2048x1536px.
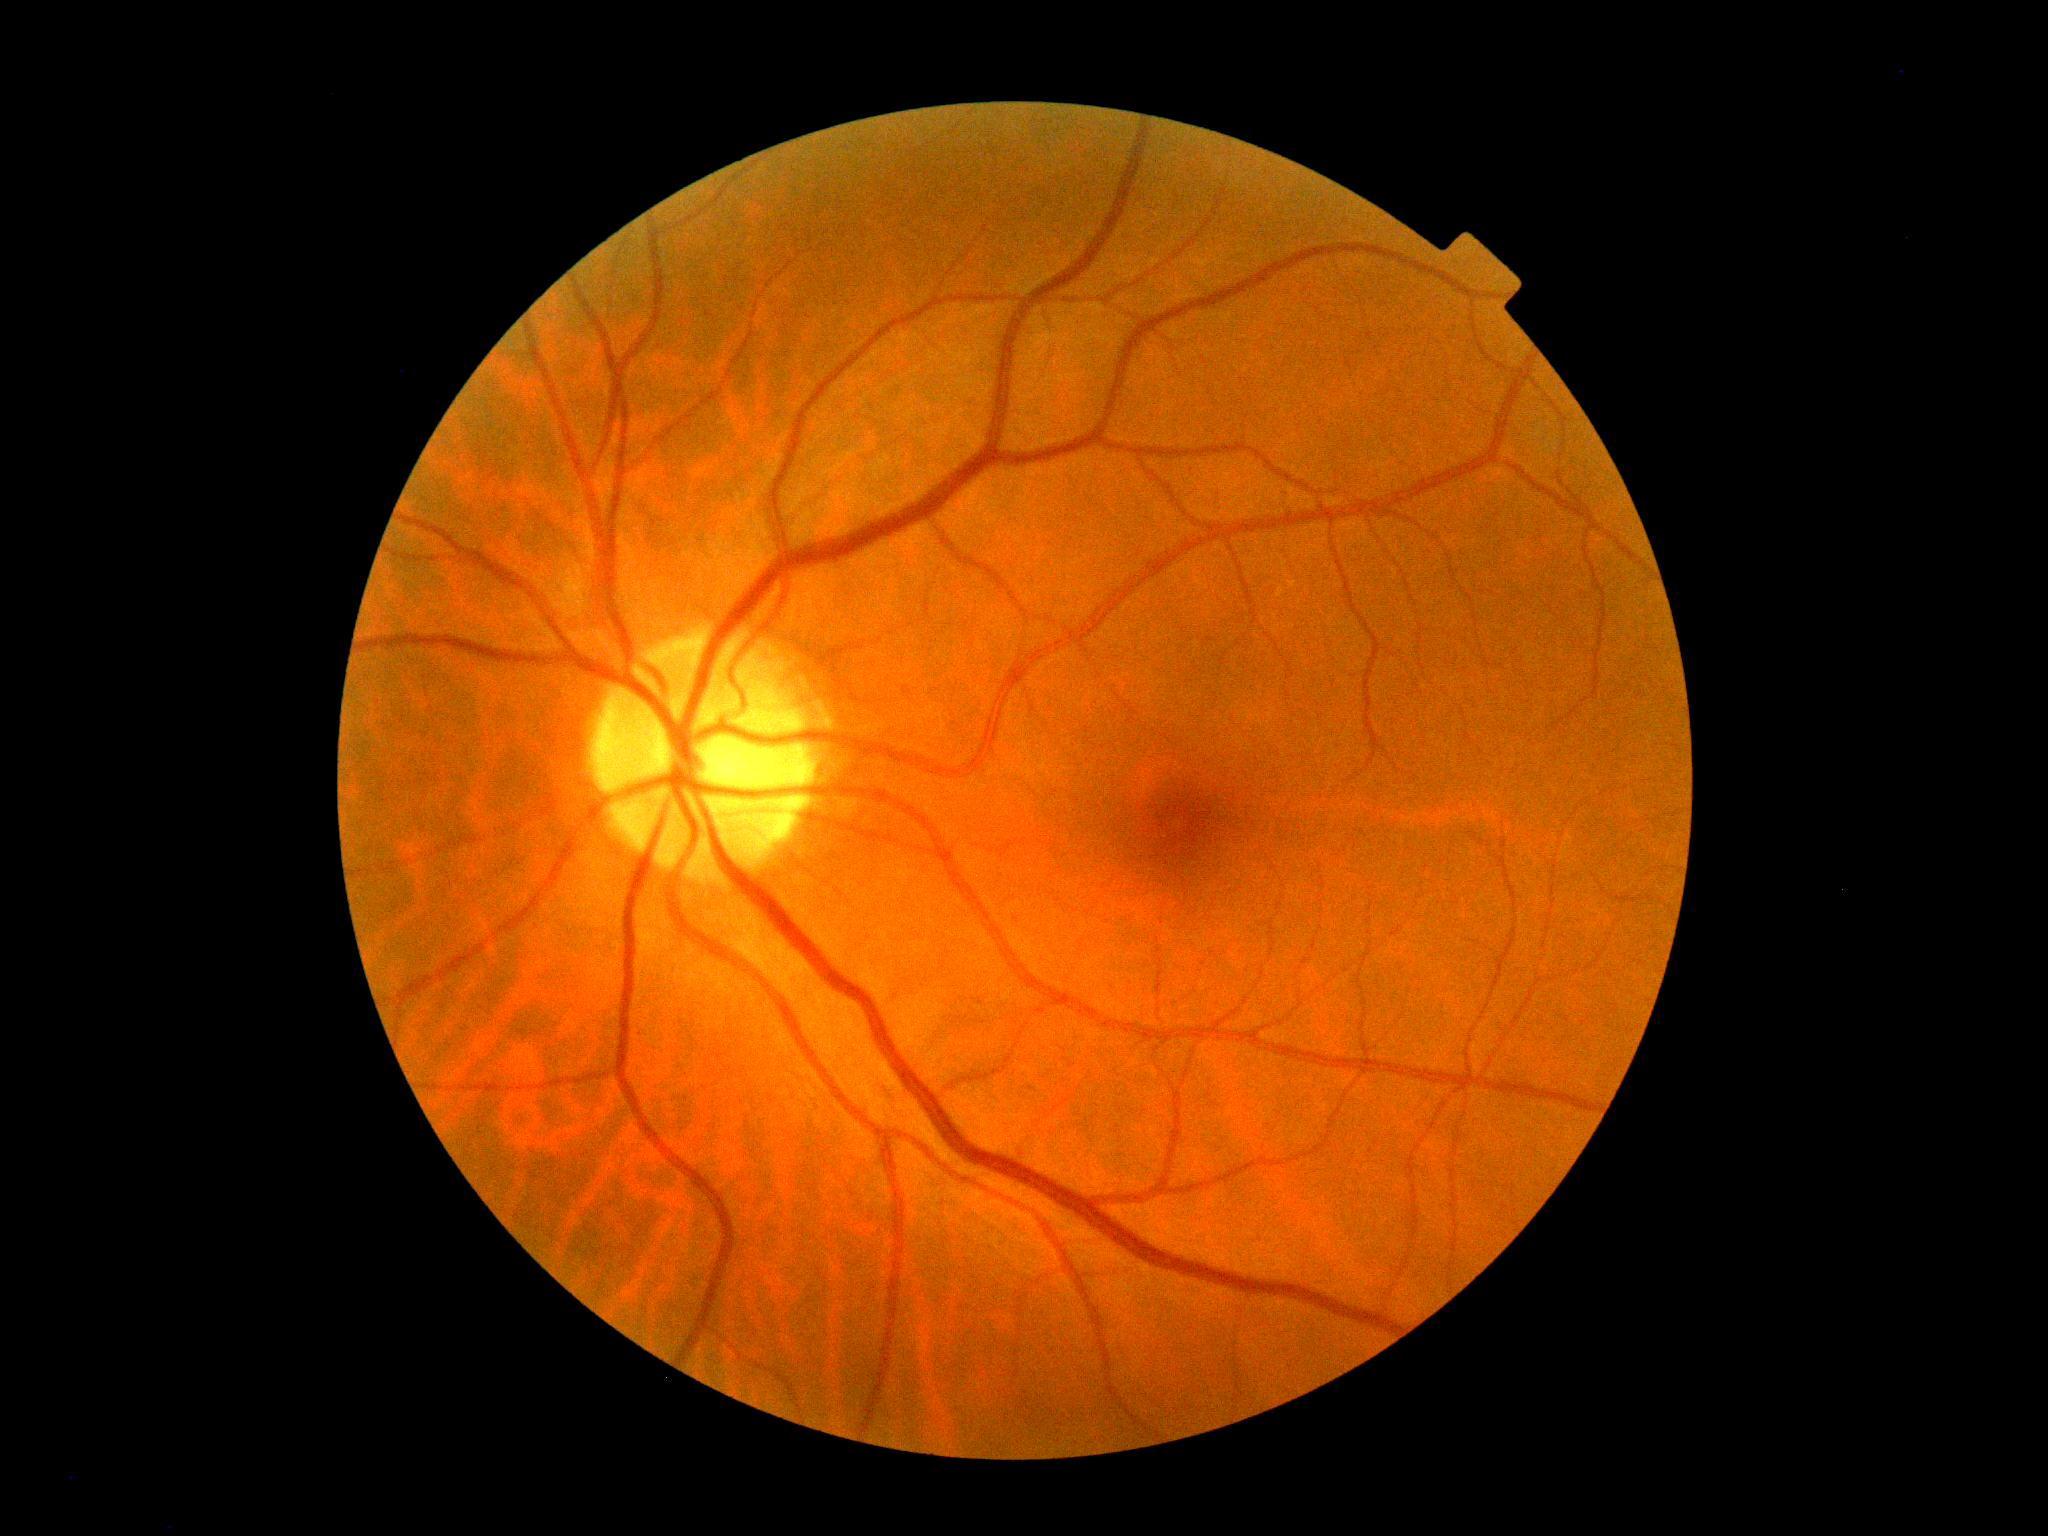 Diabetic retinopathy grade is no apparent retinopathy (0).
No apparent diabetic retinopathy.